CFP:
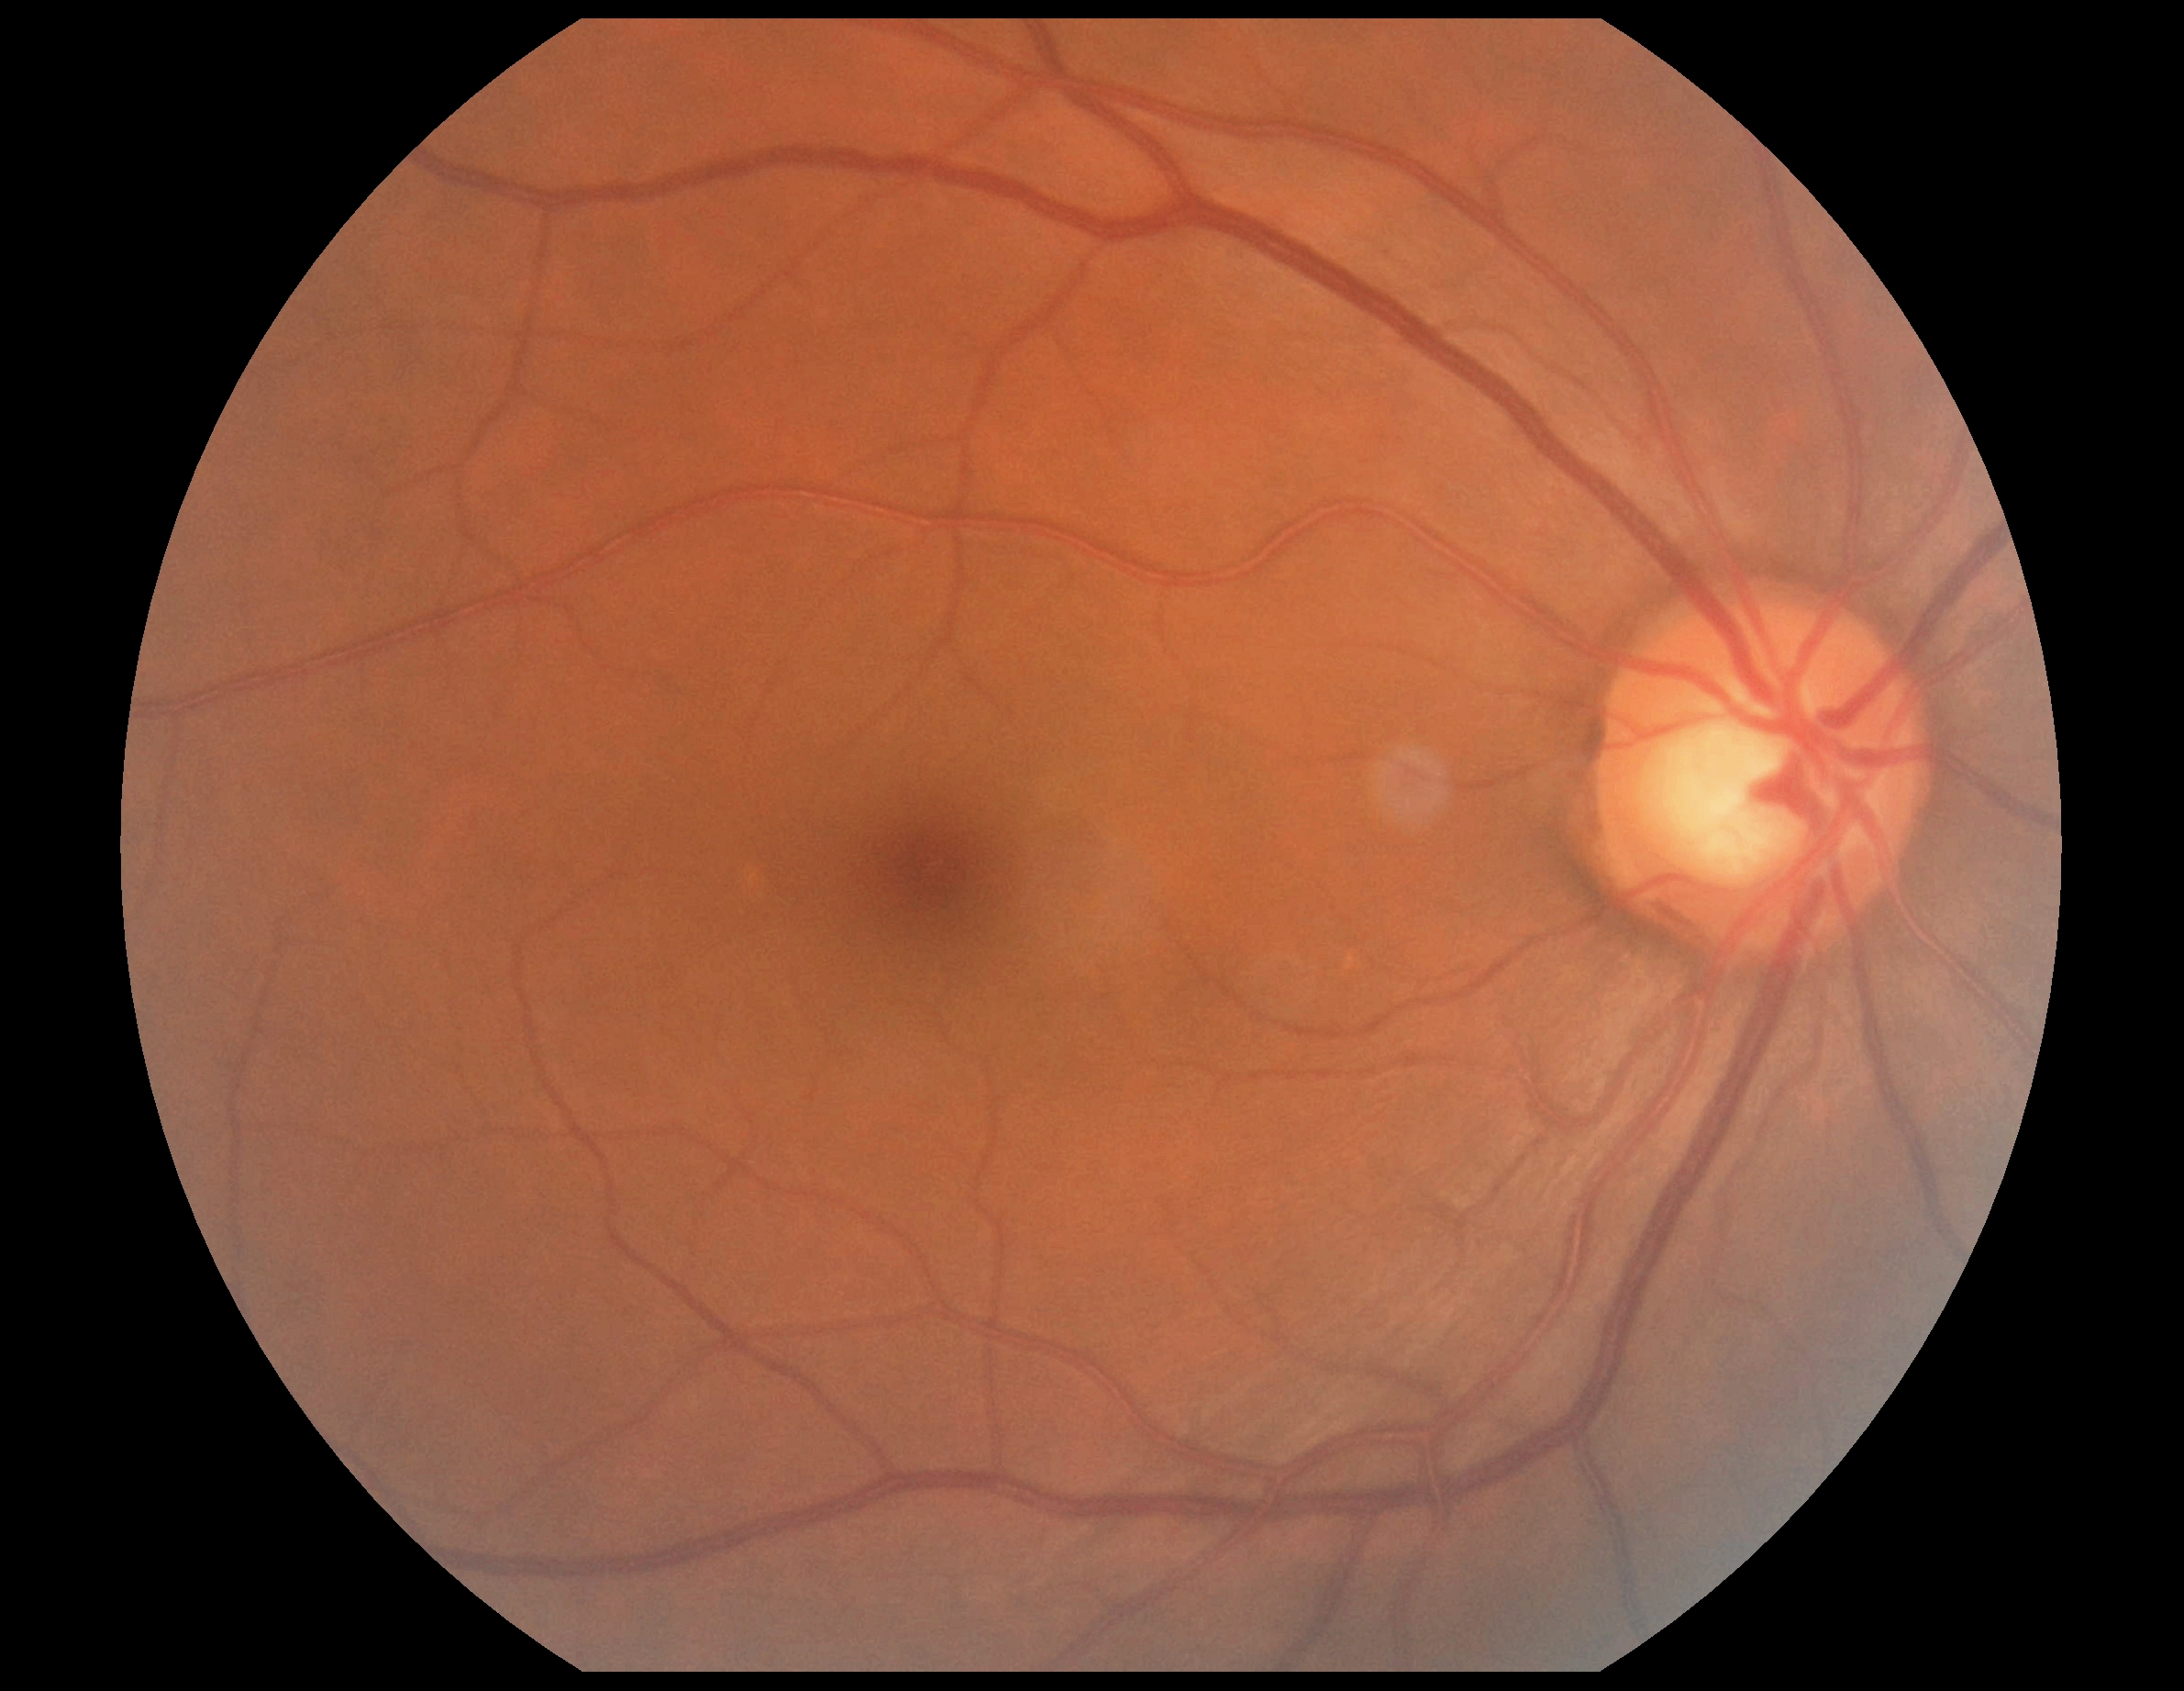
Retinopathy: grade 0.